Wide-field fundus photograph from neonatal ROP screening.
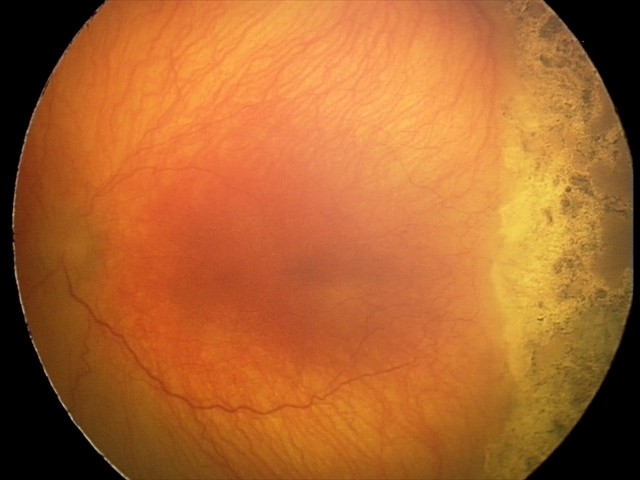 With plus disease. Screening examination consistent with aggressive retinopathy of prematurity (A-ROP).